Central posterior field · retinal fundus photograph · mydriatic (tropicamide and phenylephrine) · 50° FOV · 2228 by 1652 pixels:
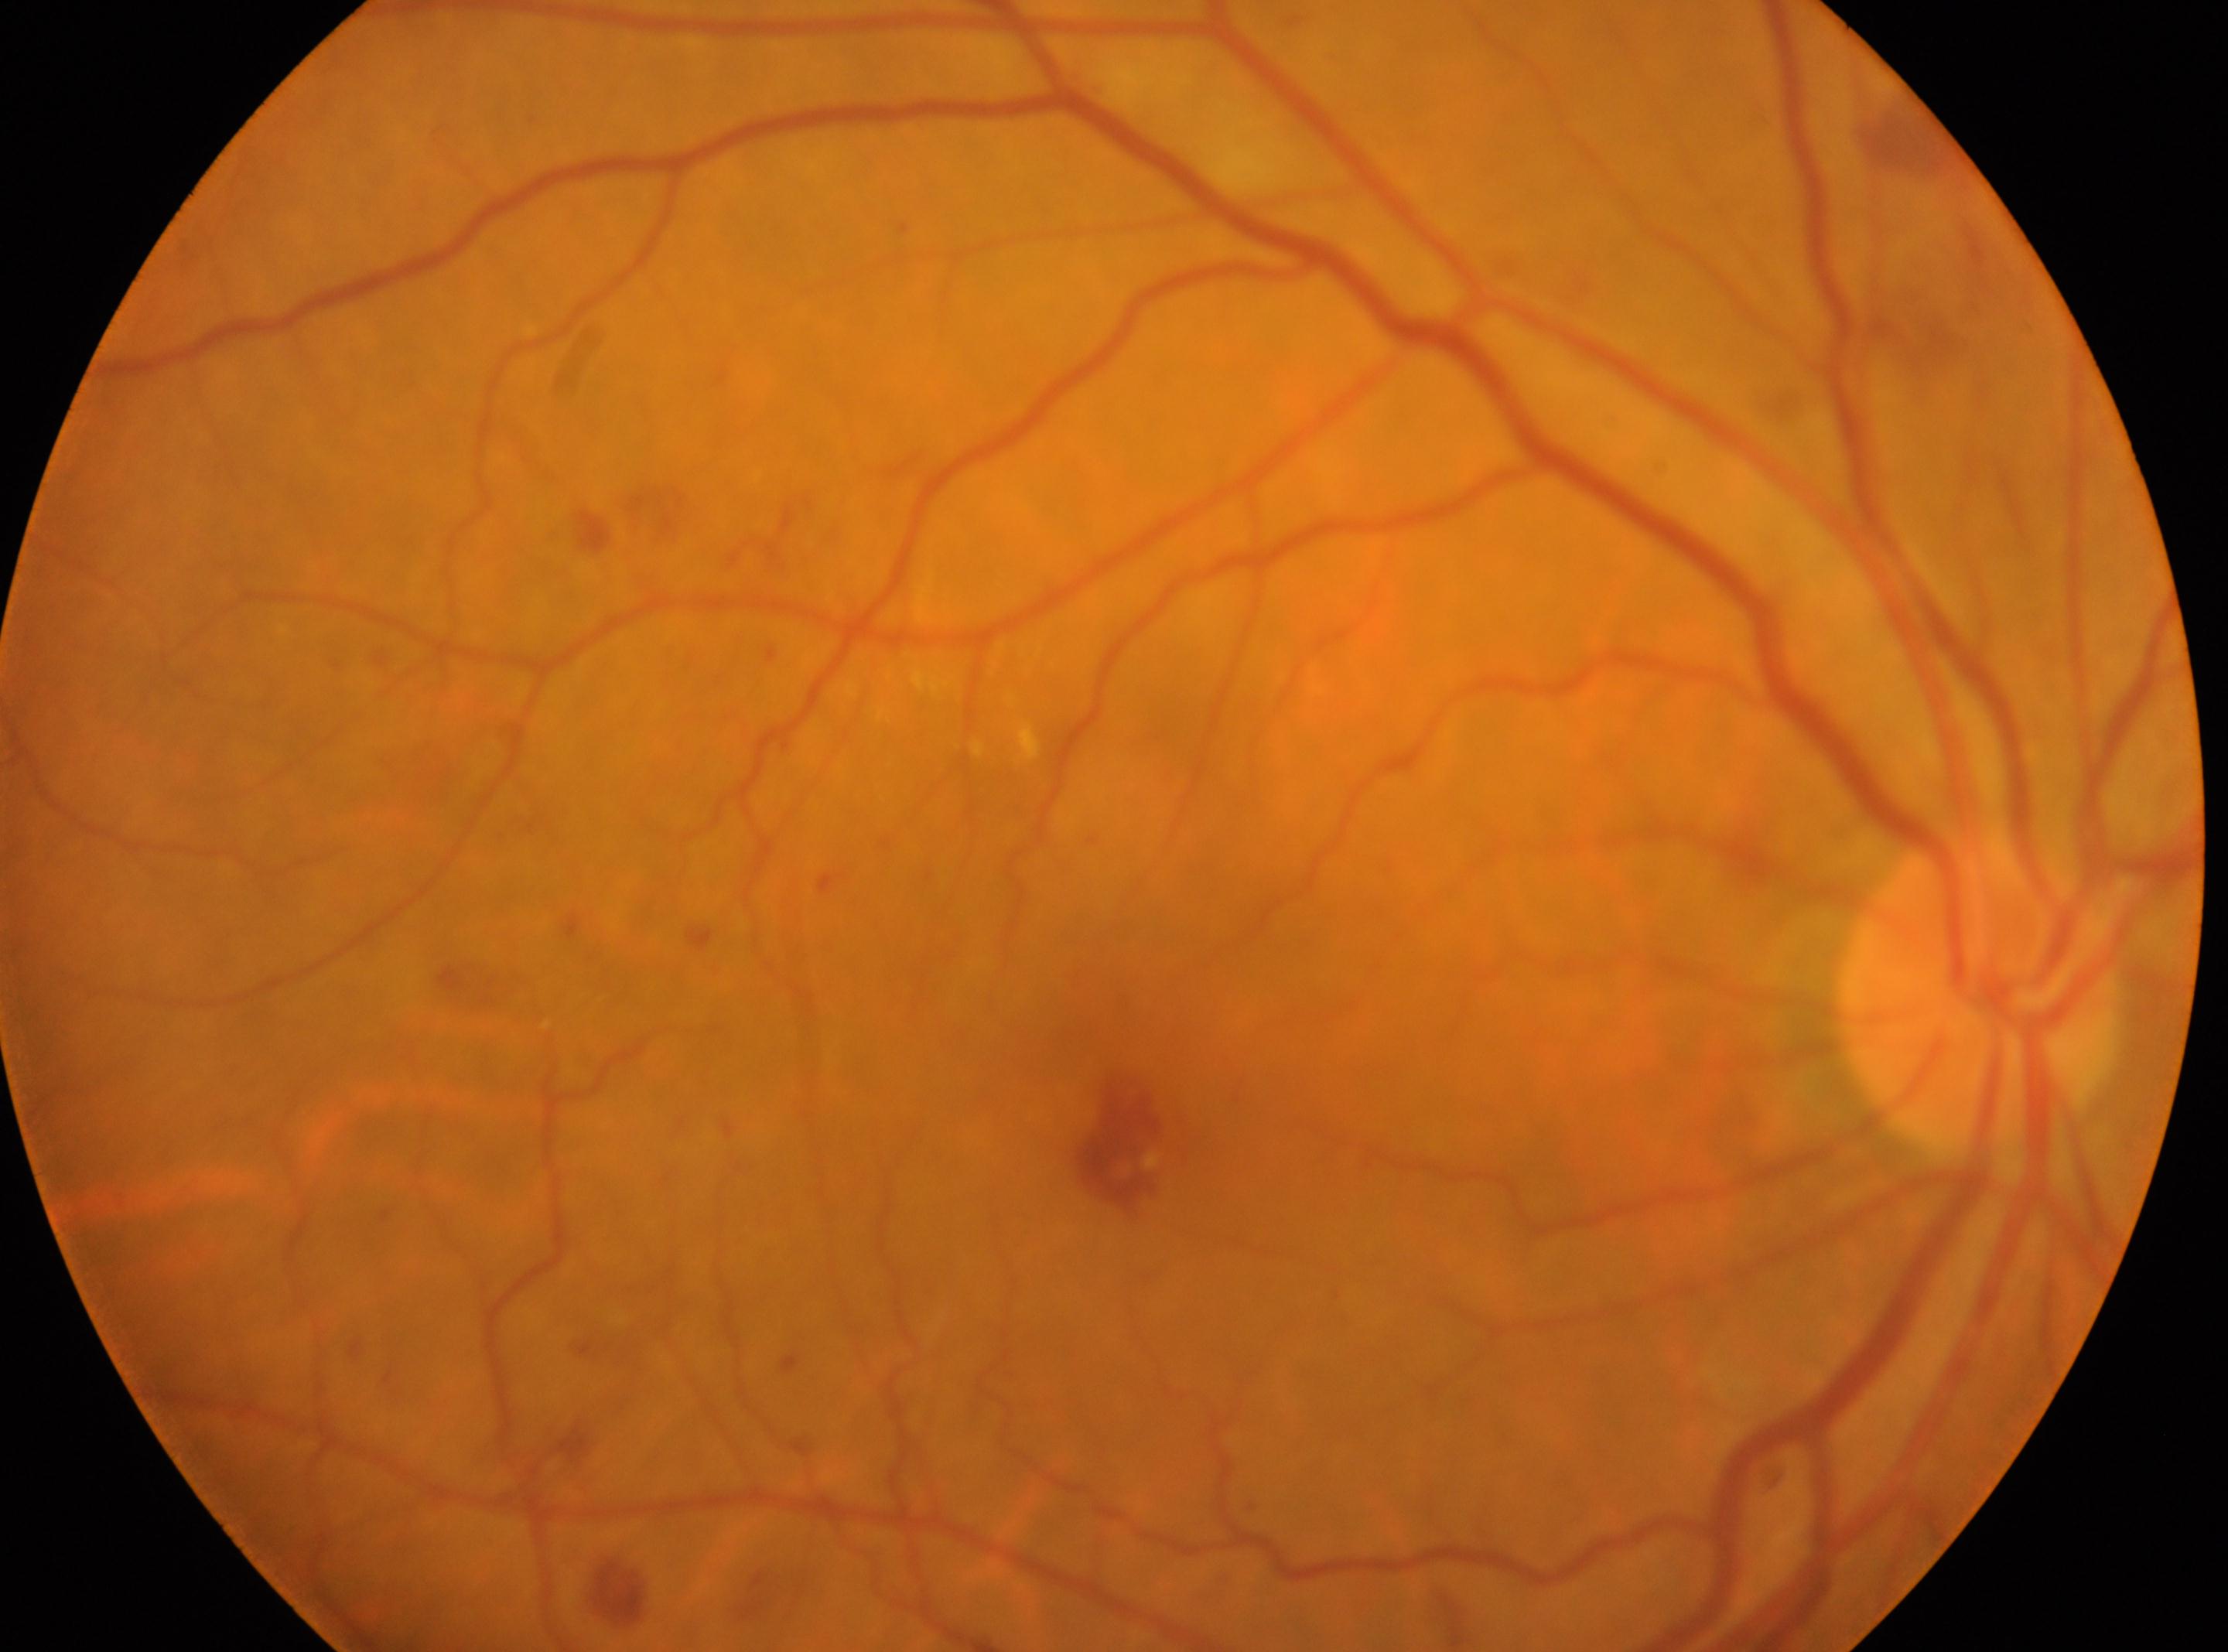 DR: moderate NPDR (grade 2).
Fovea centralis: (x=1117, y=1137).
Optic disc center located at (x=1978, y=992).
The image shows the right eye.